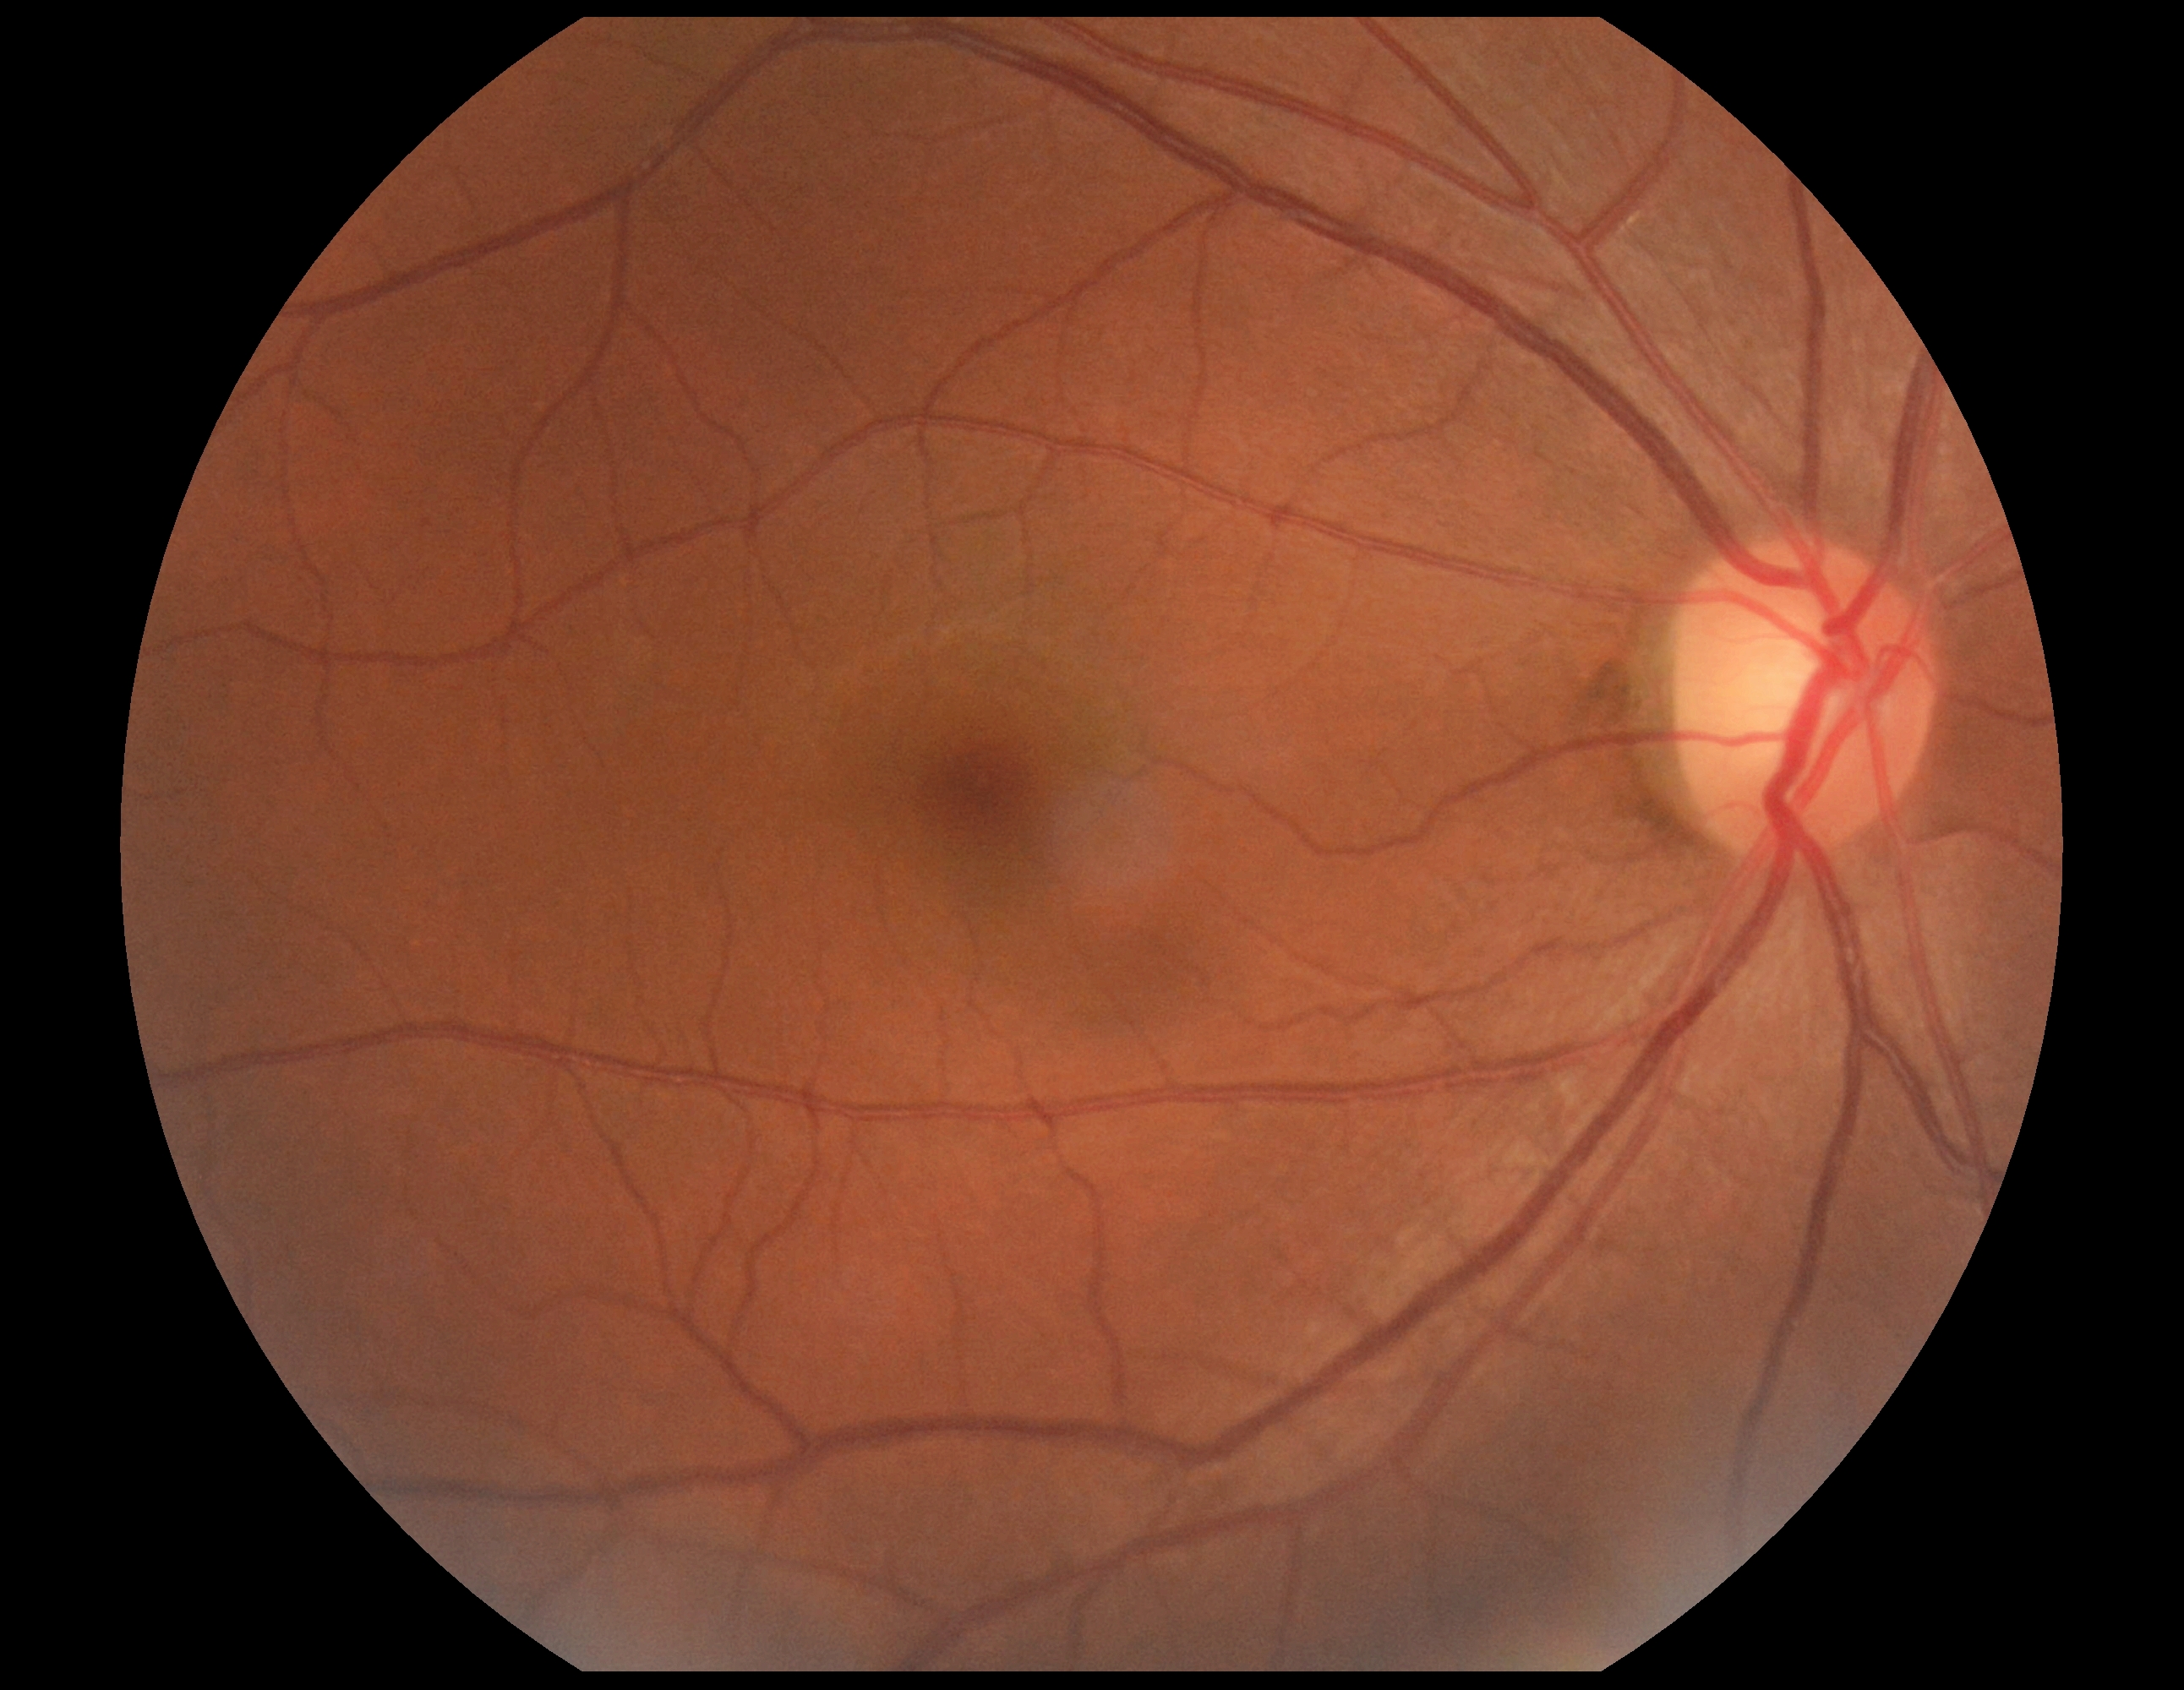 Diabetic retinopathy (DR): grade 0 — no visible signs of diabetic retinopathy.